Camera: Natus RetCam Envision (130° FOV). Infant wide-field retinal image
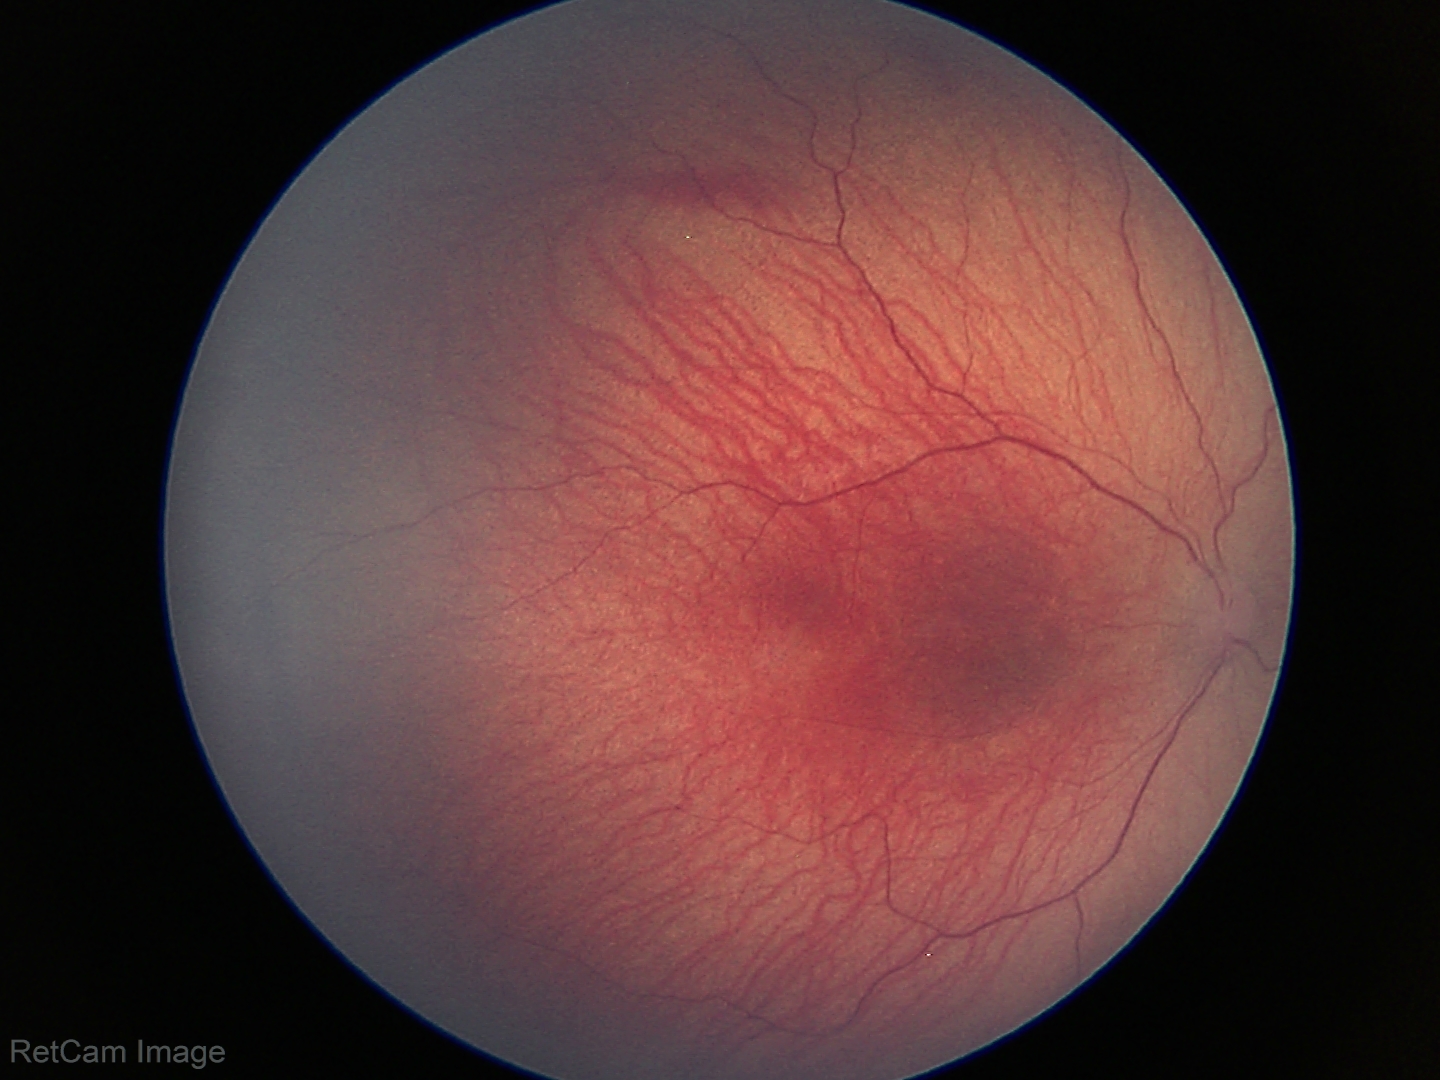 From an examination with diagnosis of retinopathy of prematurity stage 1.